CFP, 2184 by 1690 pixels:
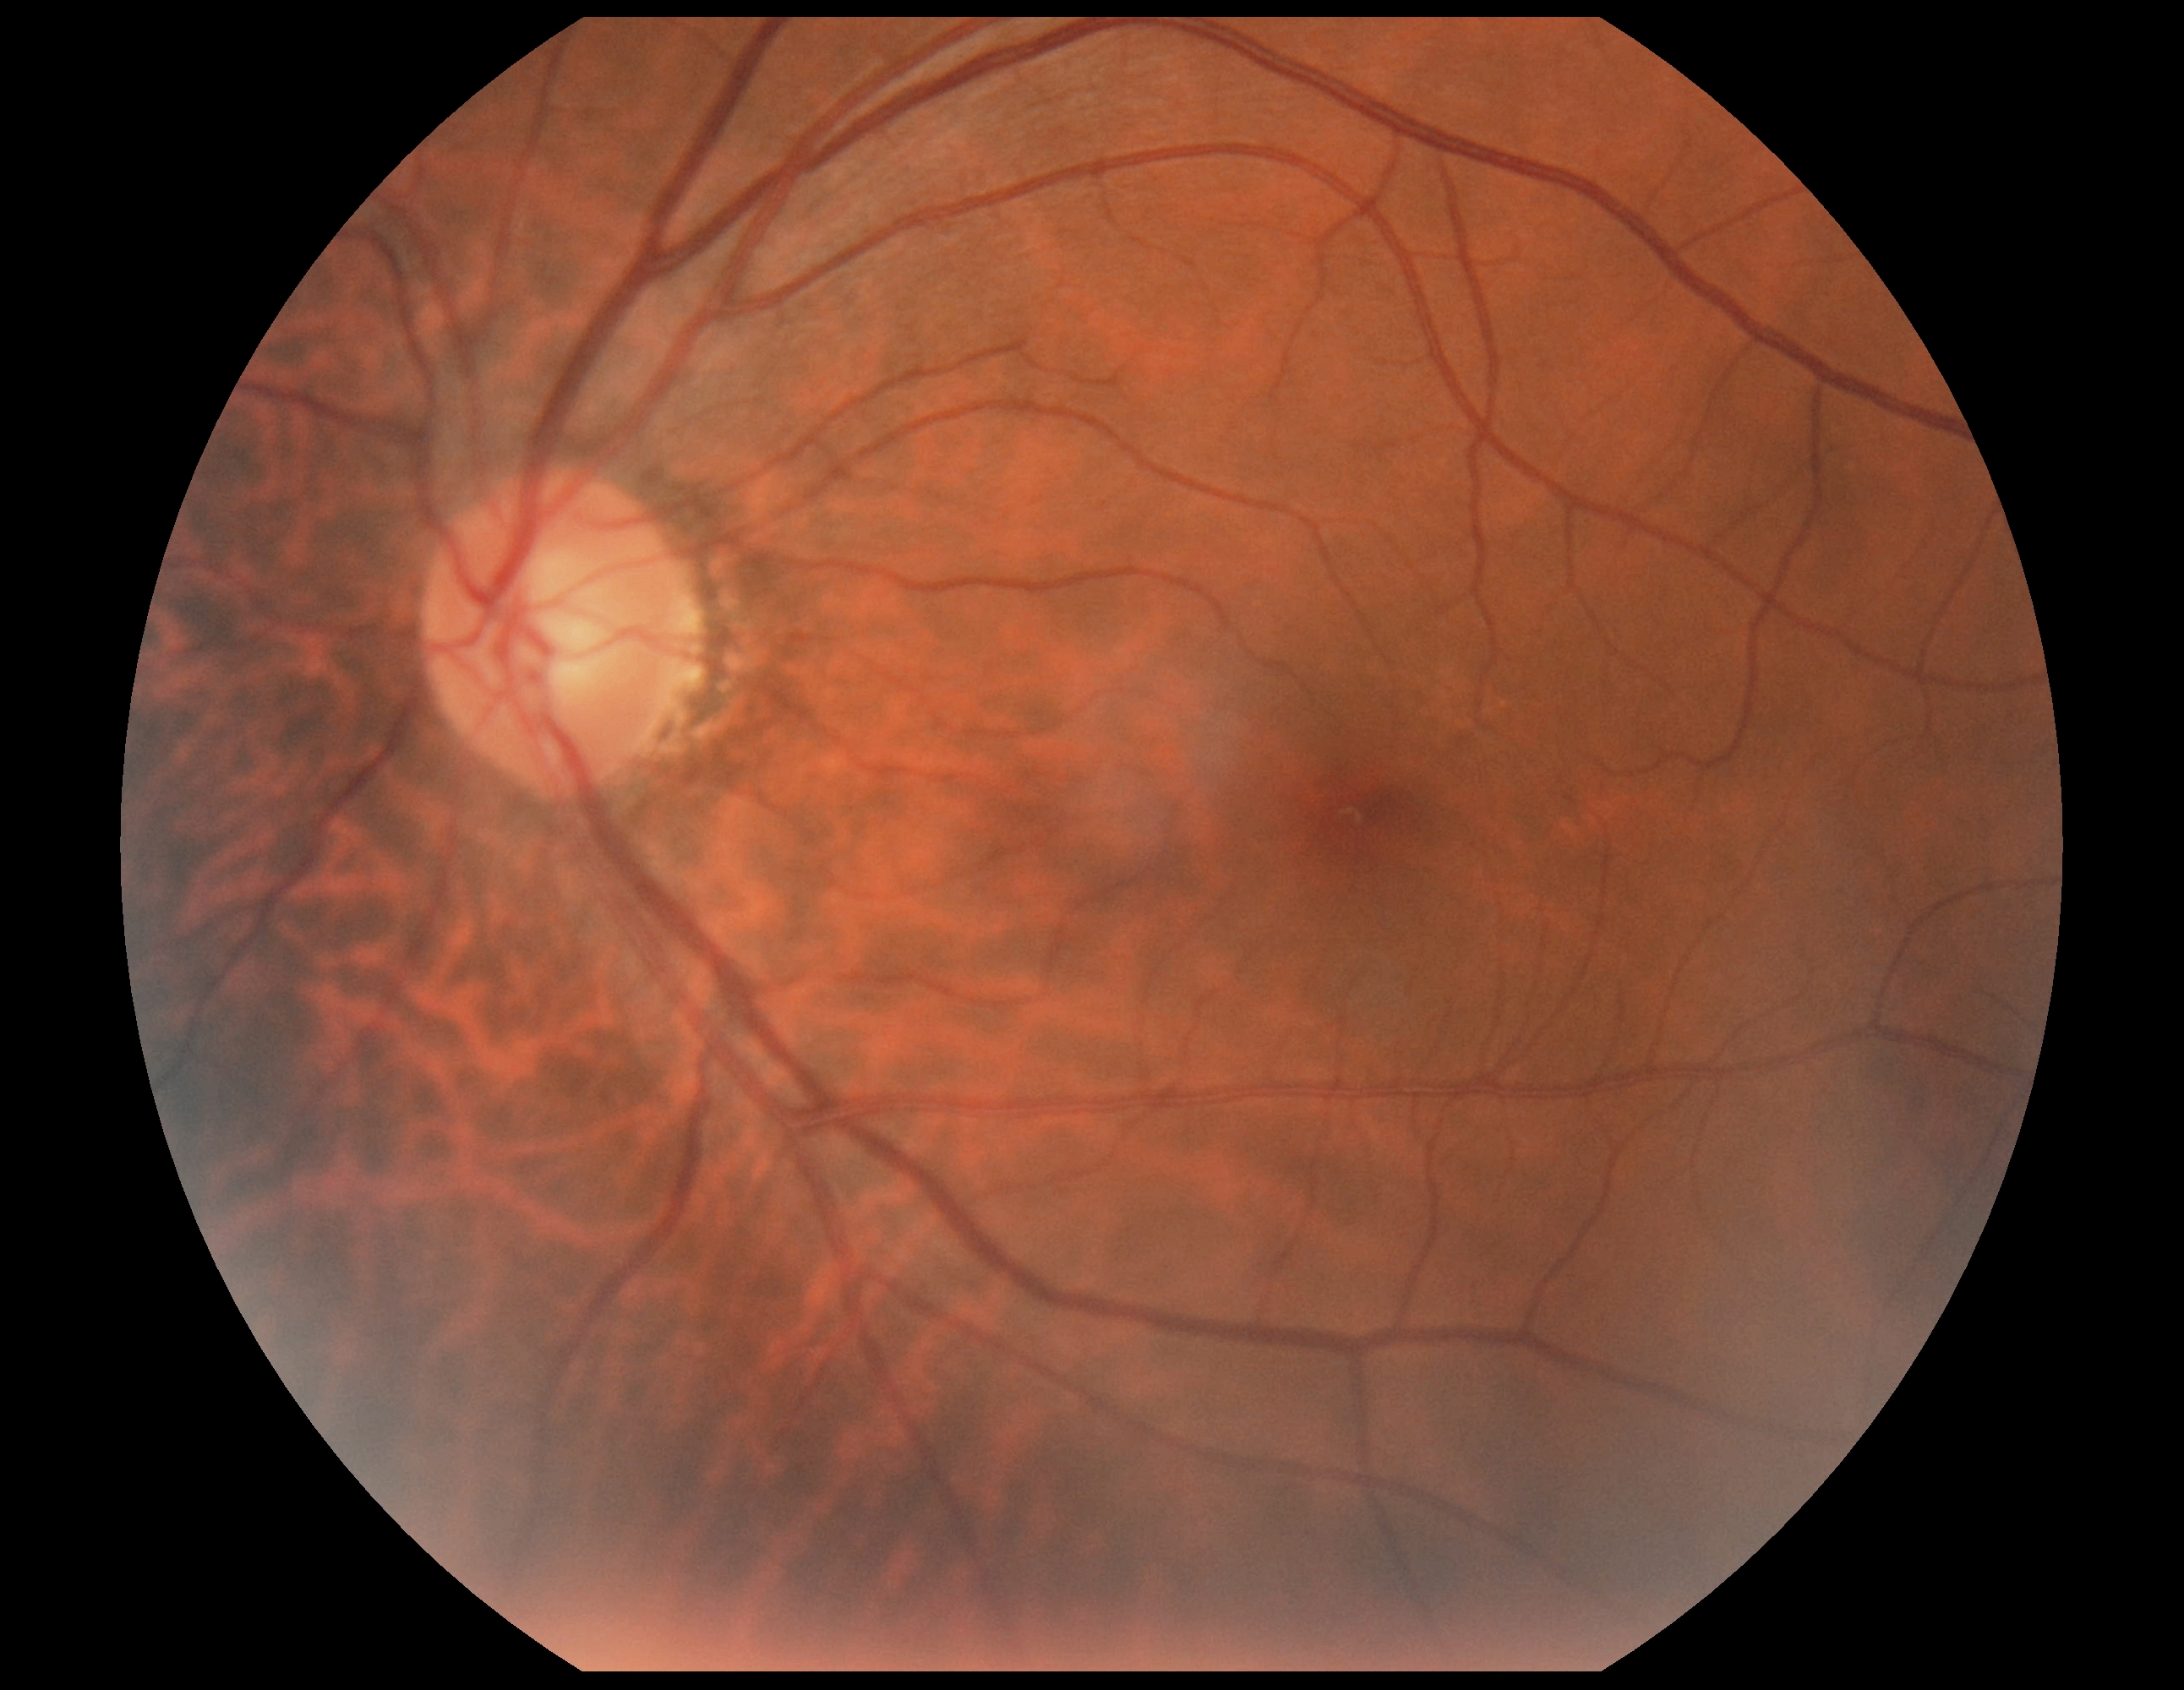 Retinopathy grade is 0/4.